NIDEK AFC-230 fundus camera; CFP; image size 848x848: 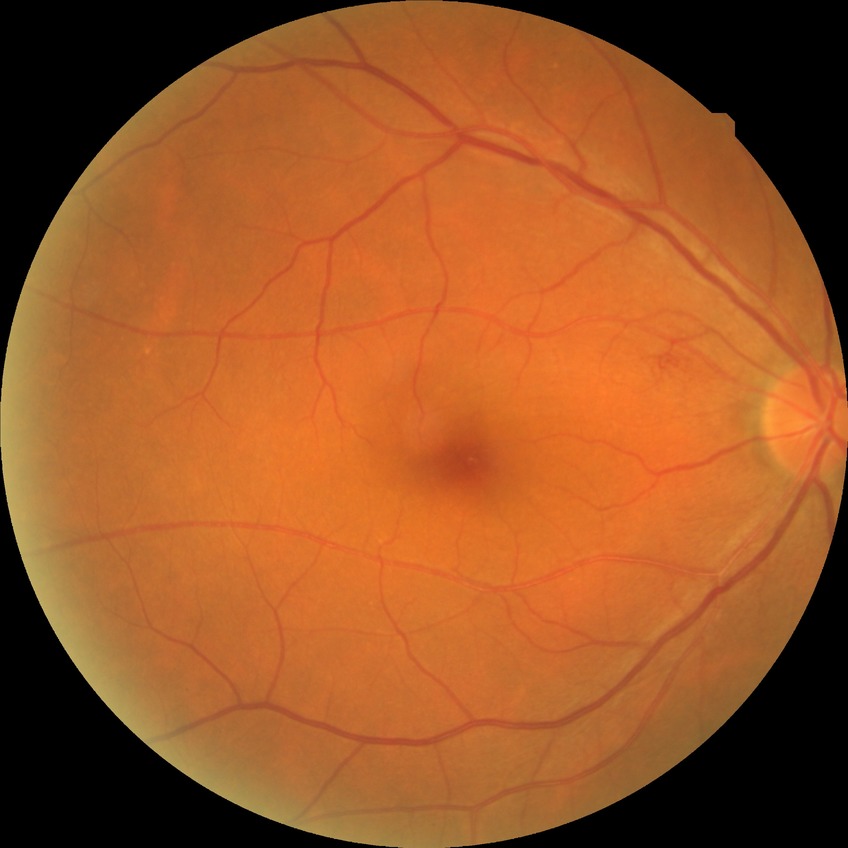

Assessment:
* diabetic retinopathy (DR) — simple diabetic retinopathy (SDR)